Color fundus image — 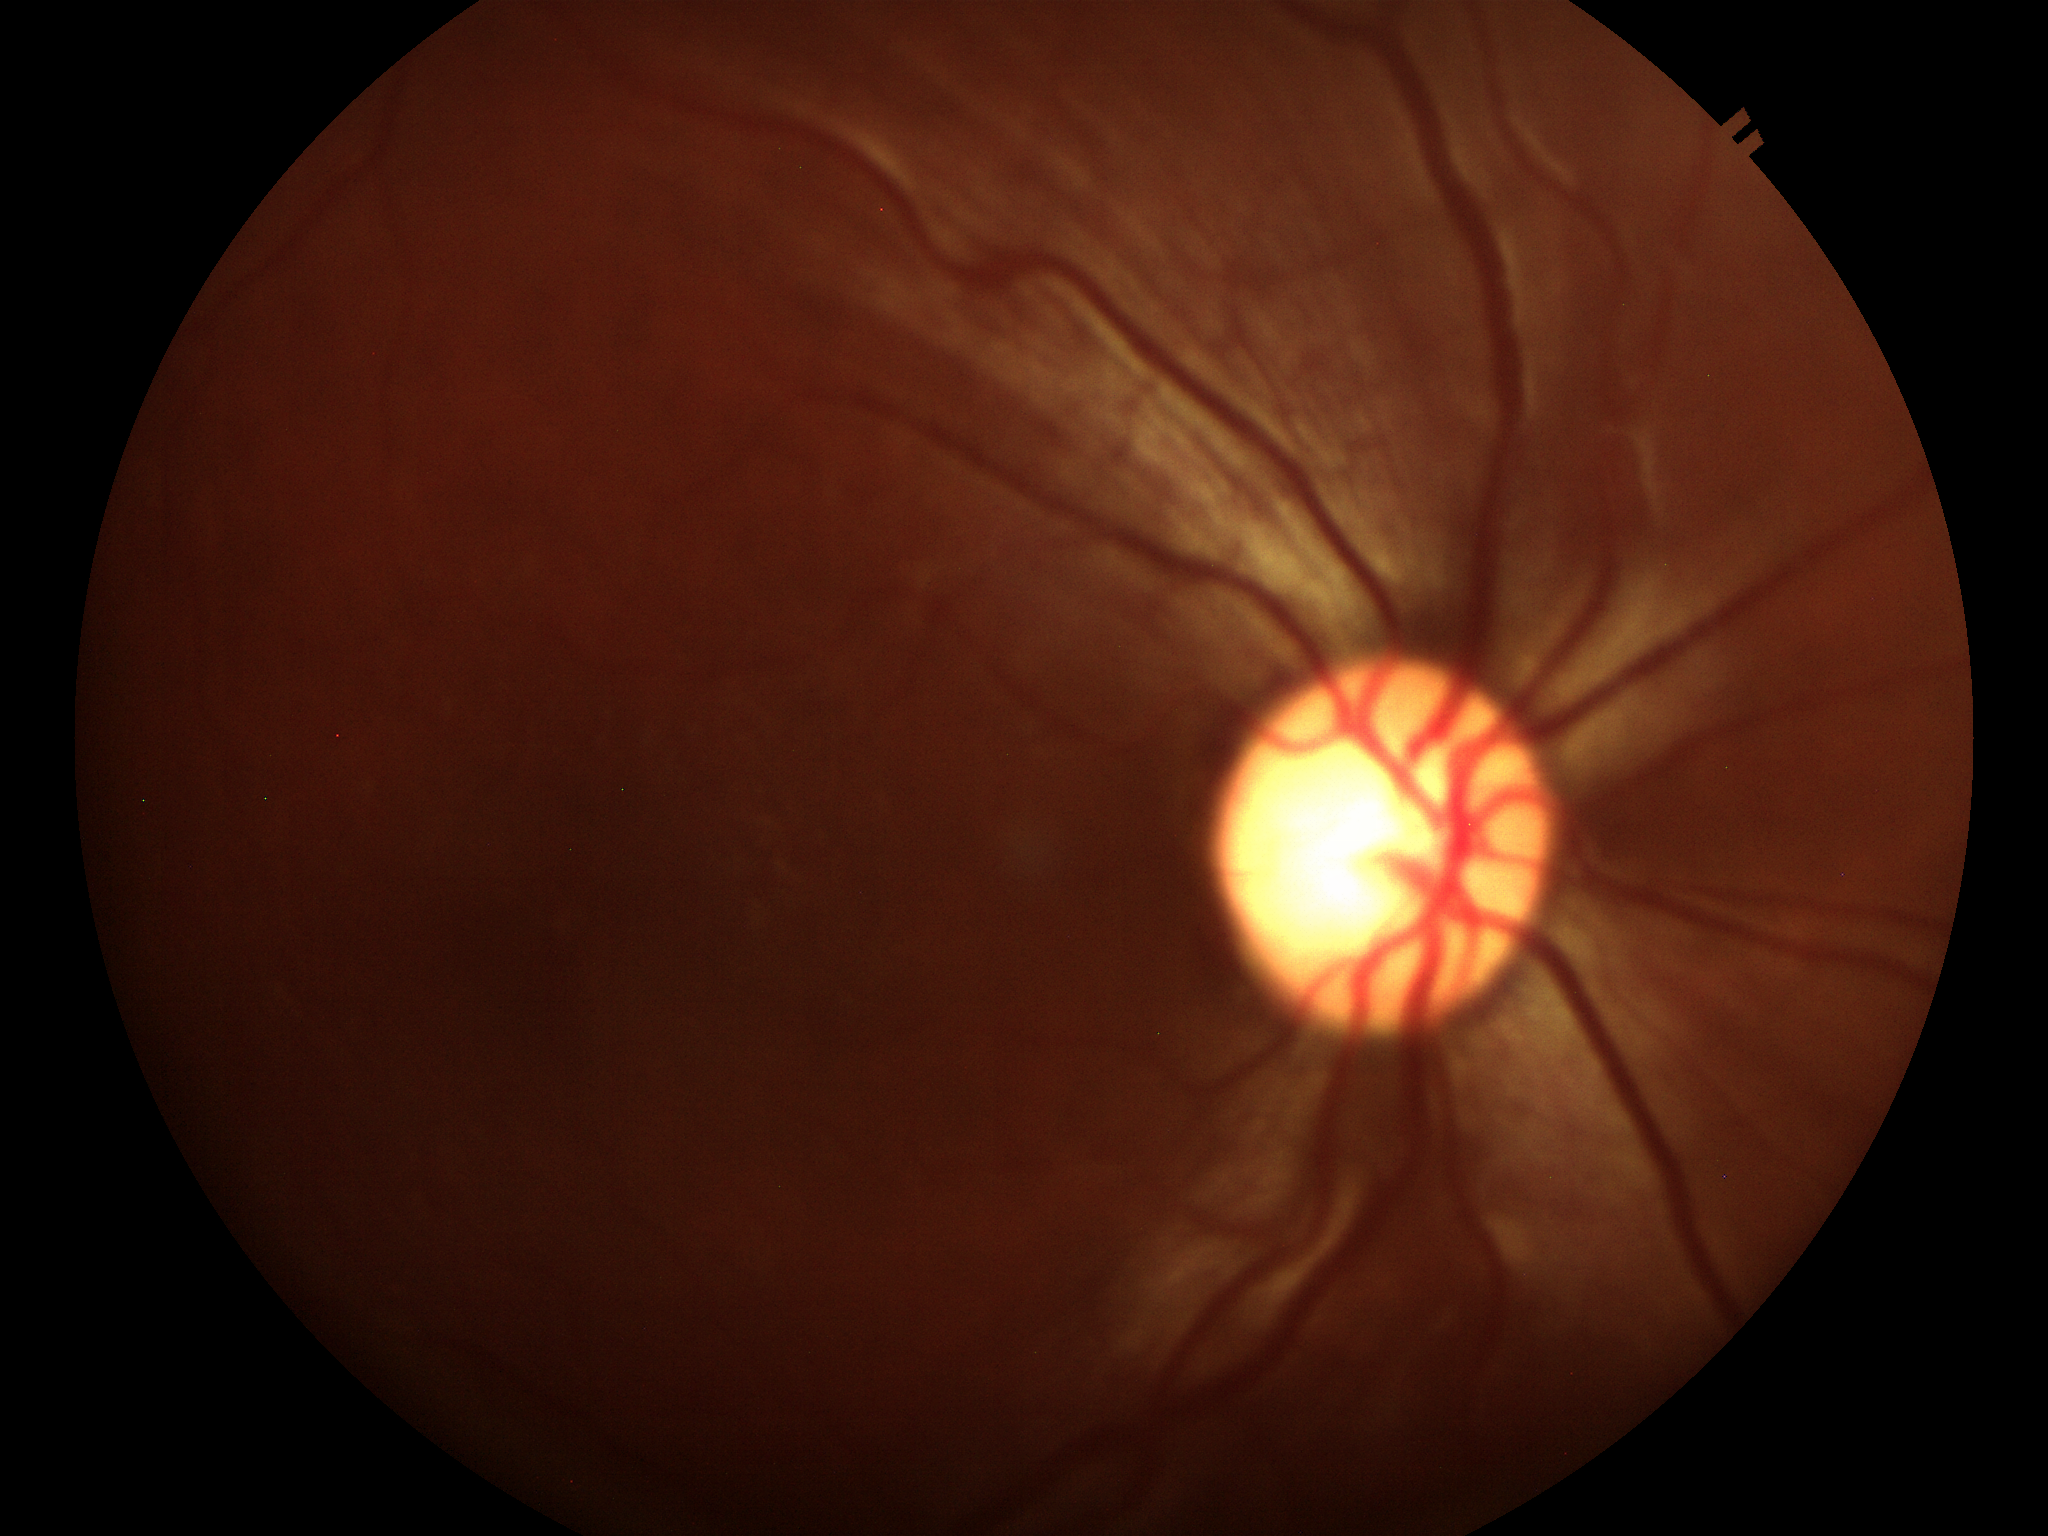

Glaucoma decision: suspect (4/5 graders called glaucoma suspect). VCDR of 0.60.